45-degree field of view
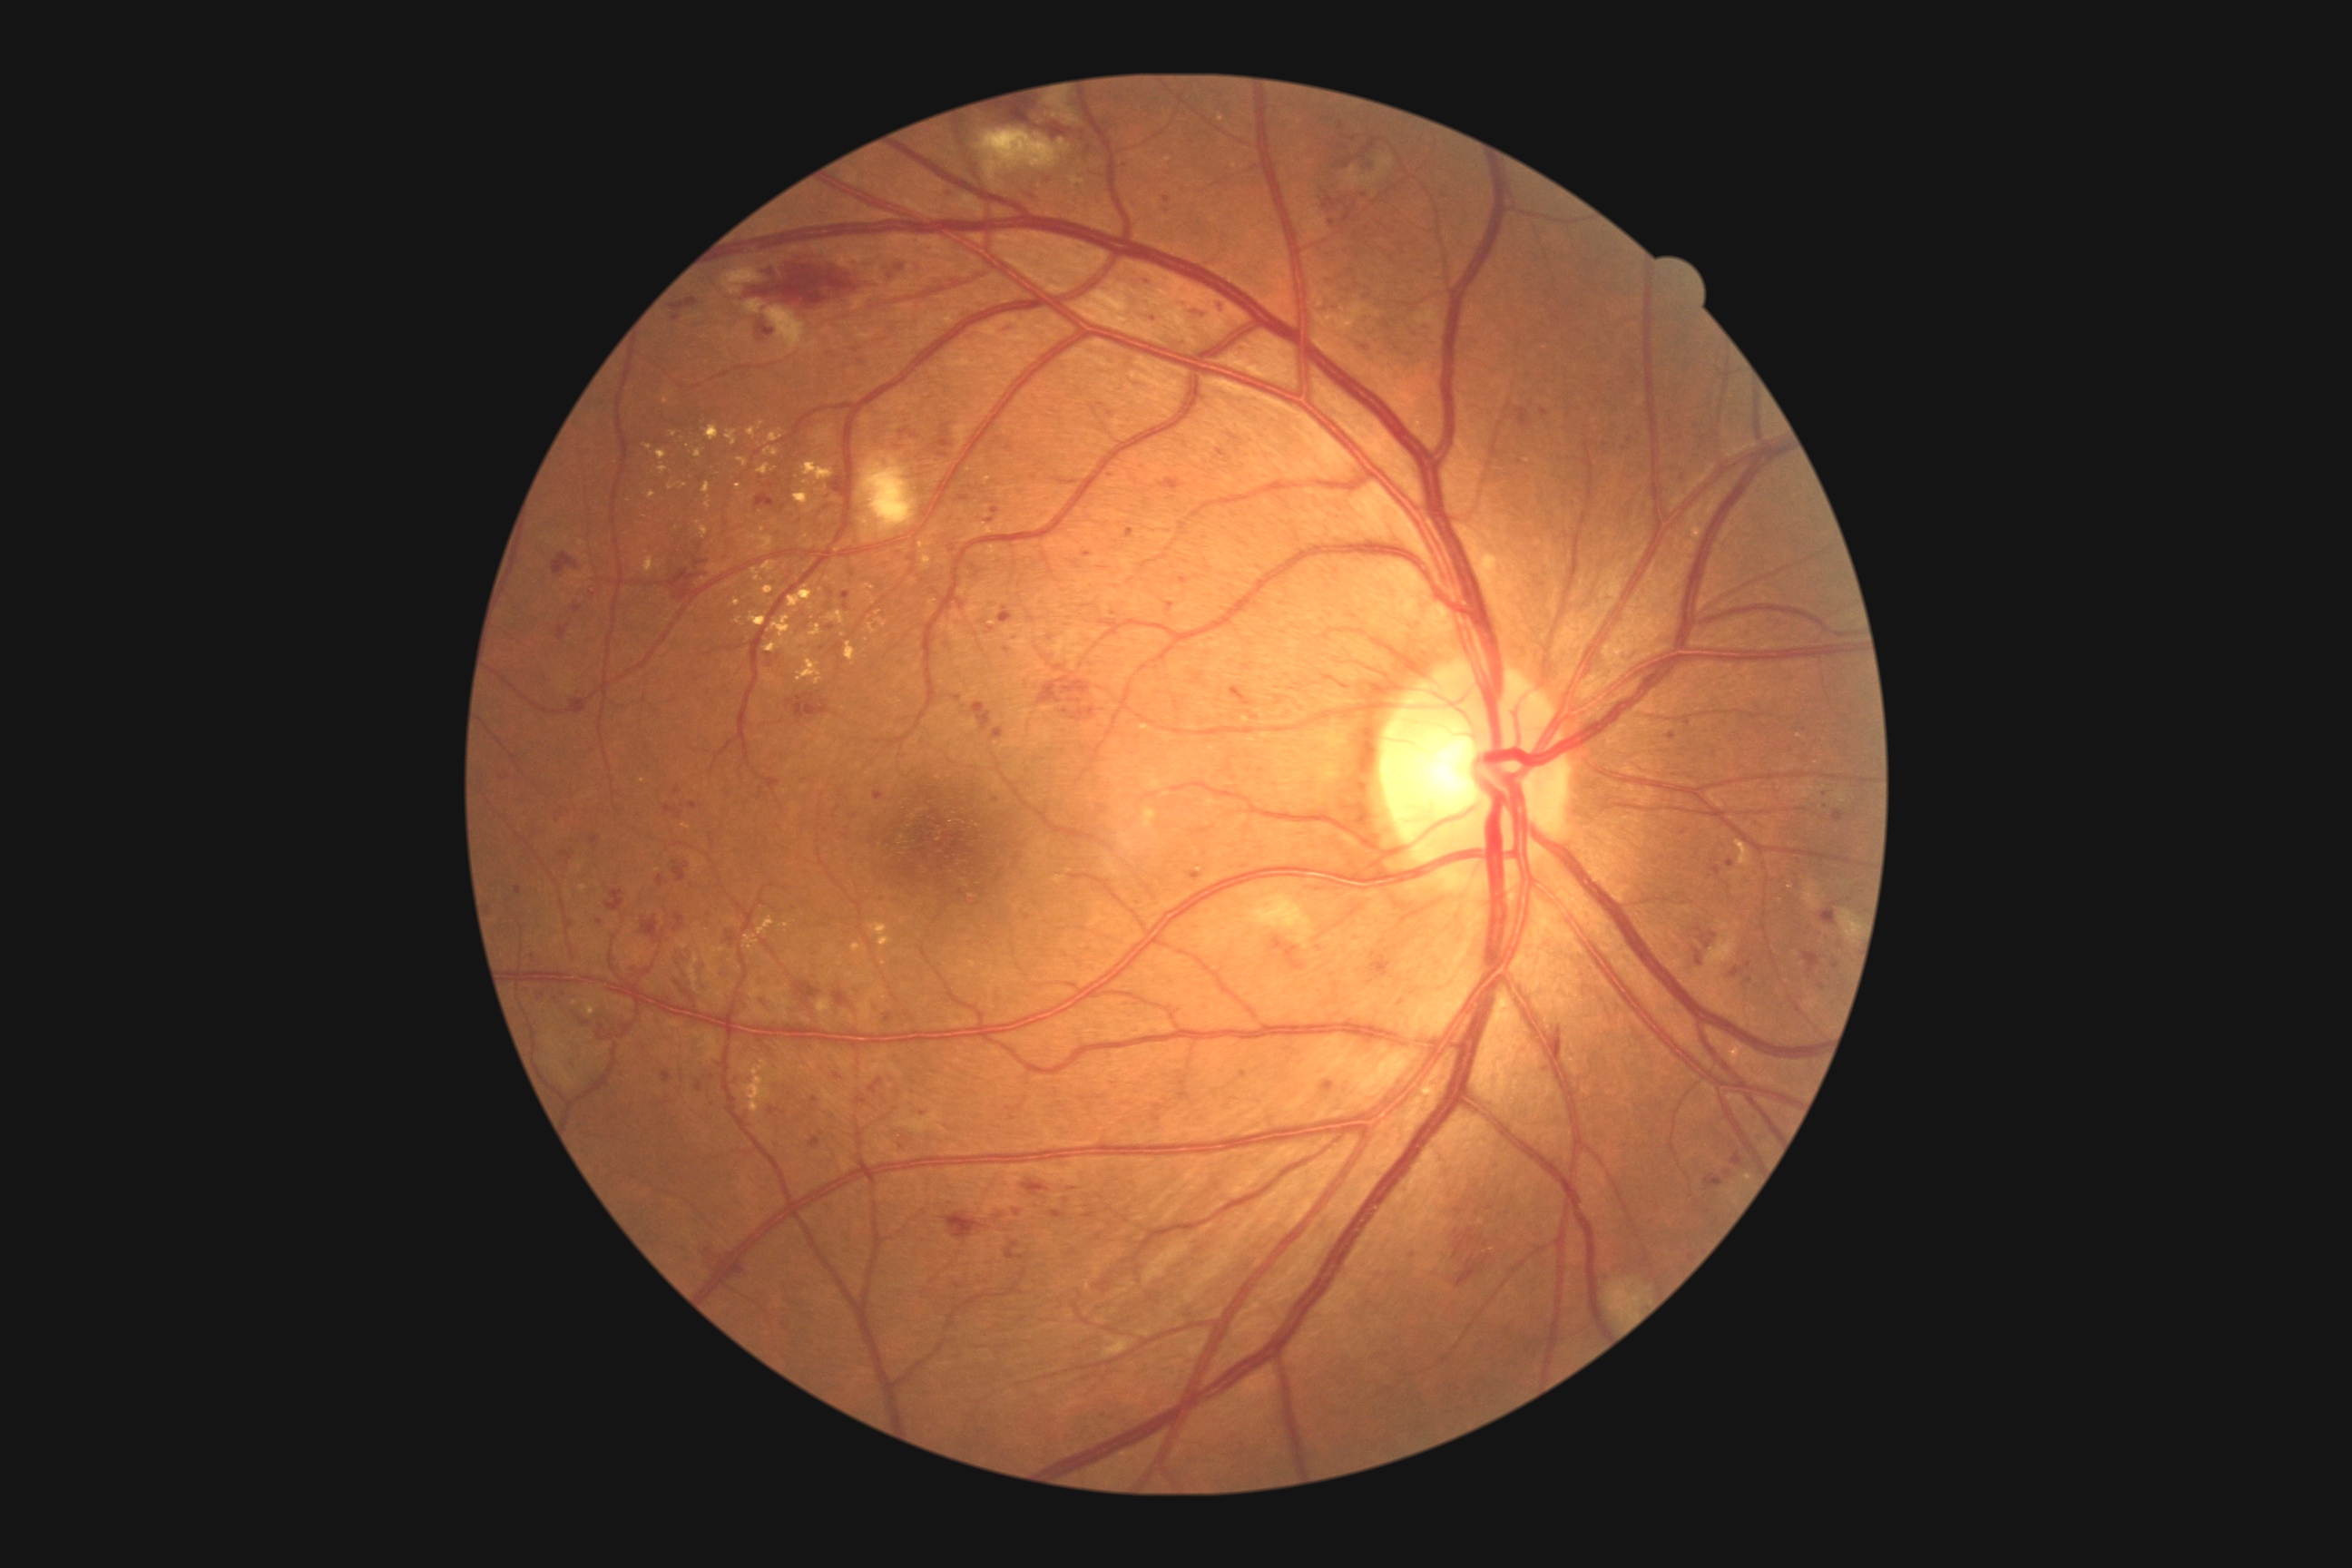 DR grade is 3/4.